Retinal fundus photograph
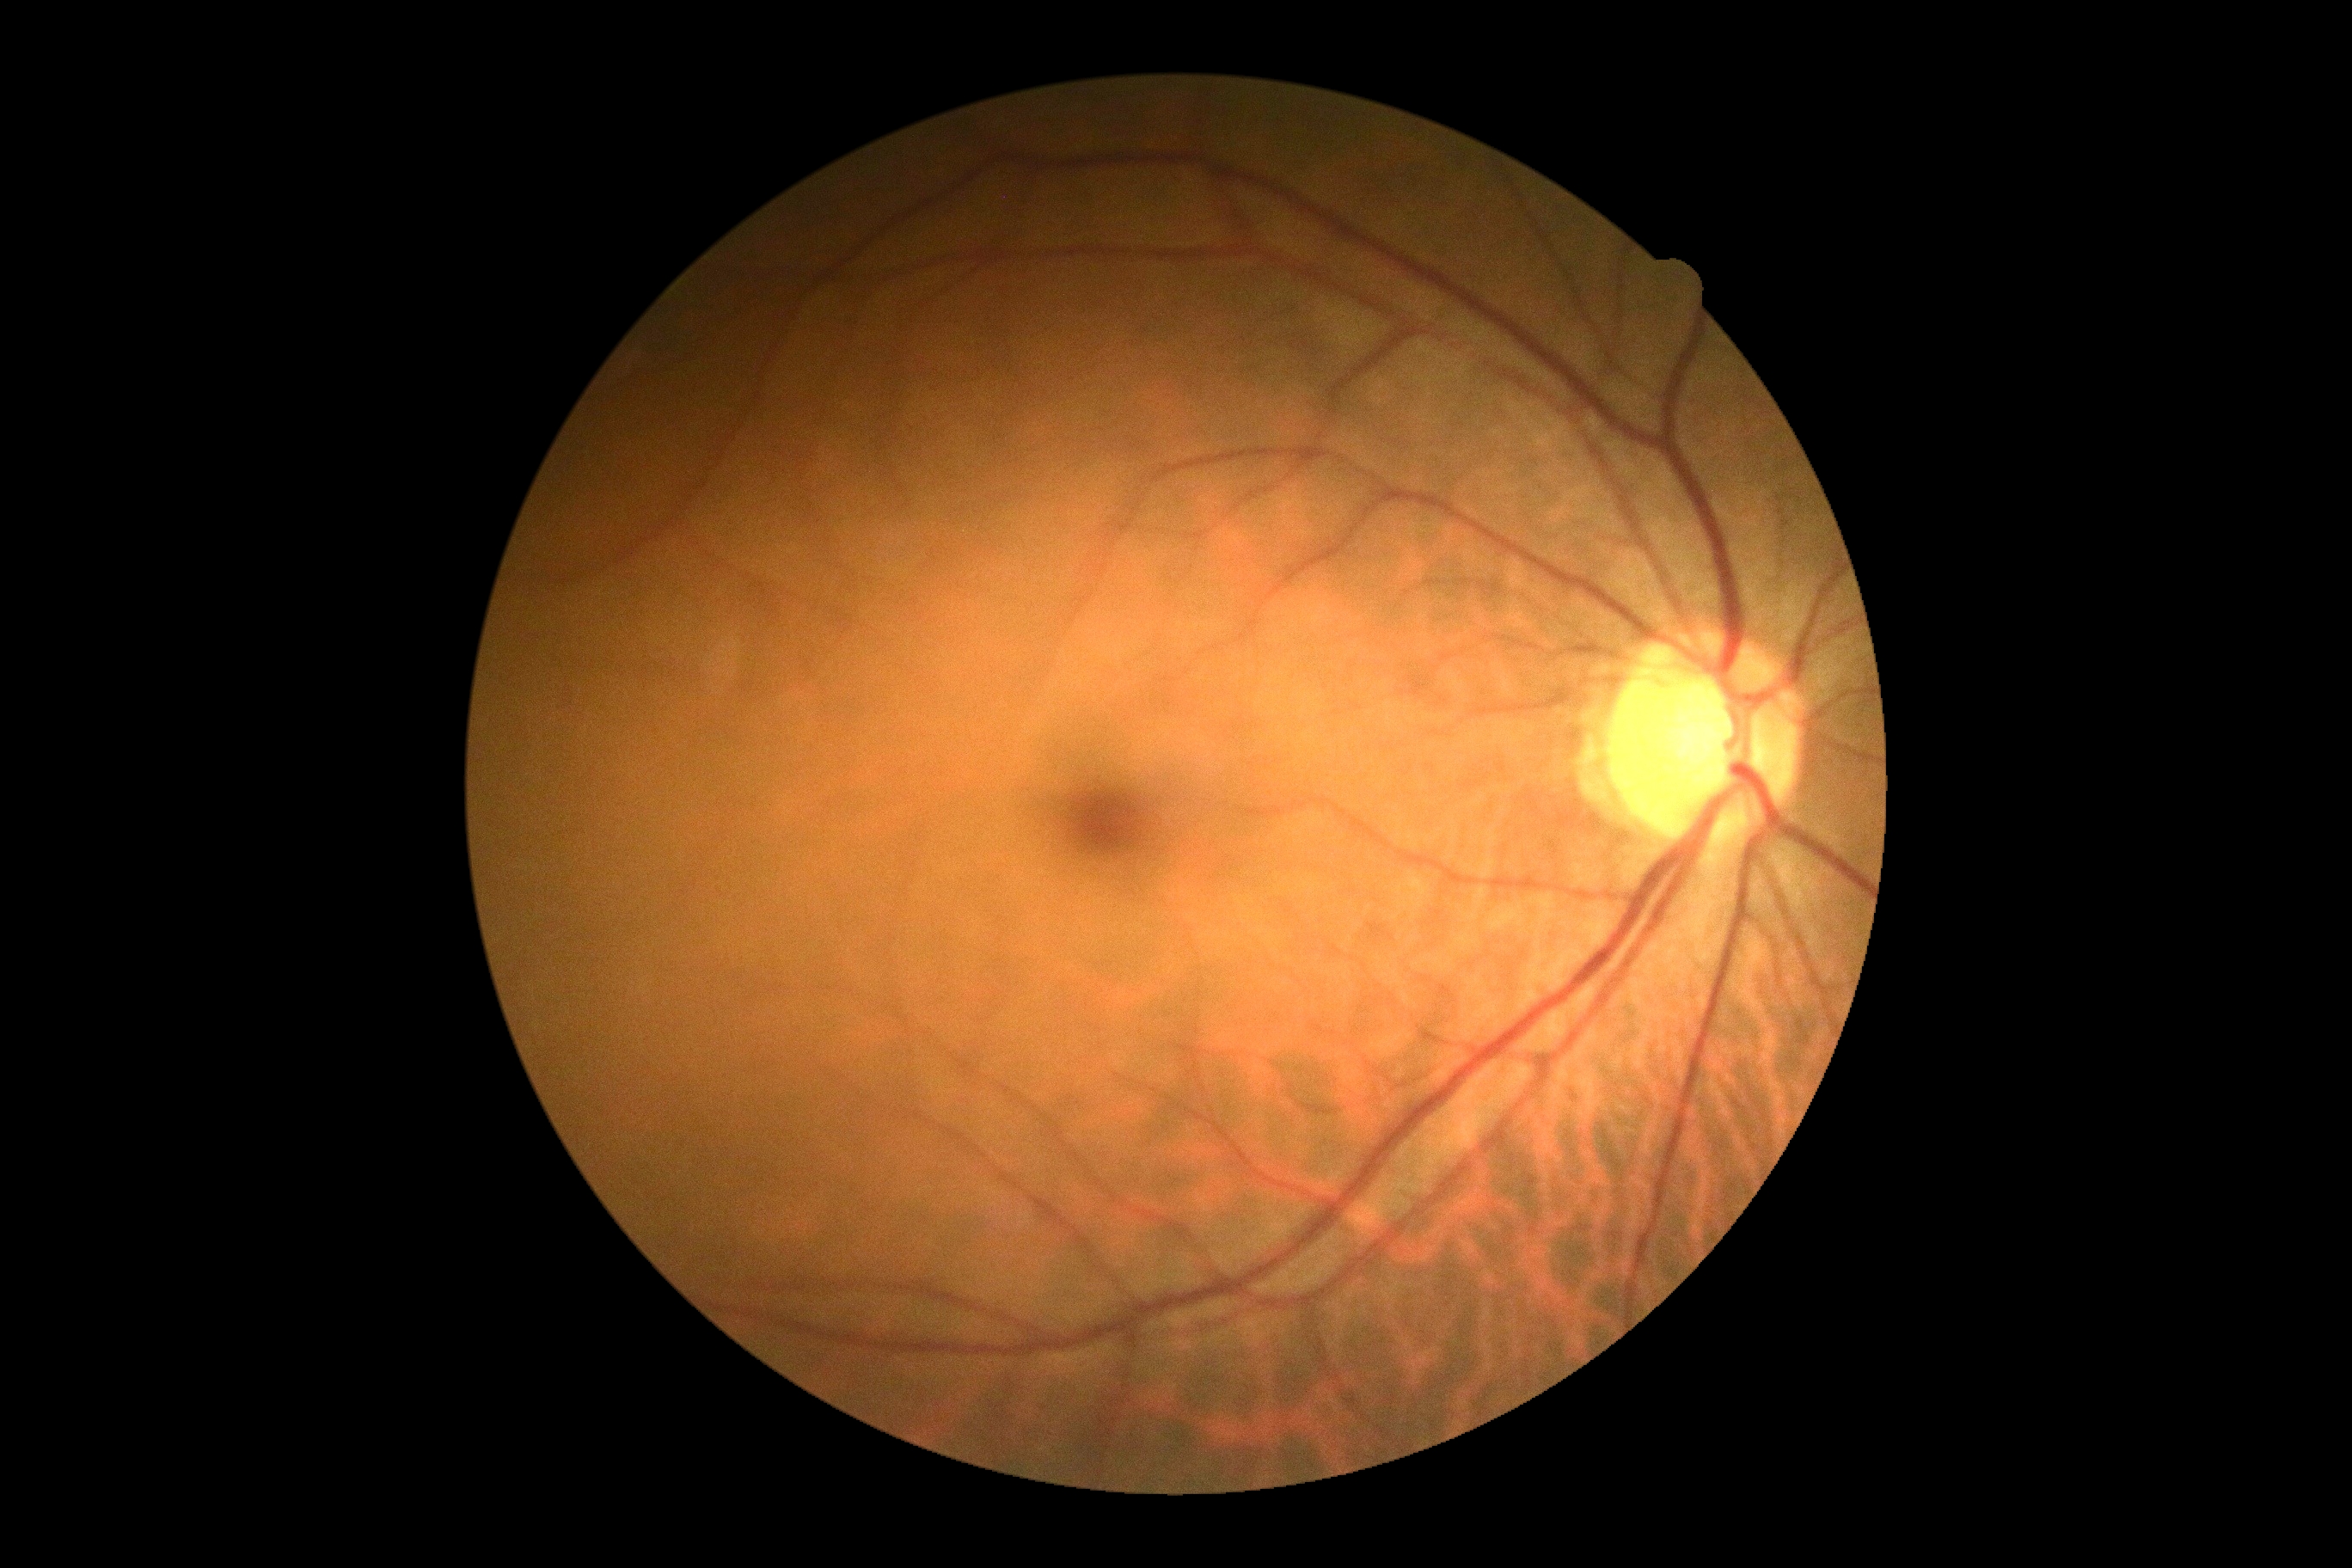
Annotations:
• diabetic retinopathy (DR): no apparent retinopathy (grade 0)
• DR impression: no DR findings